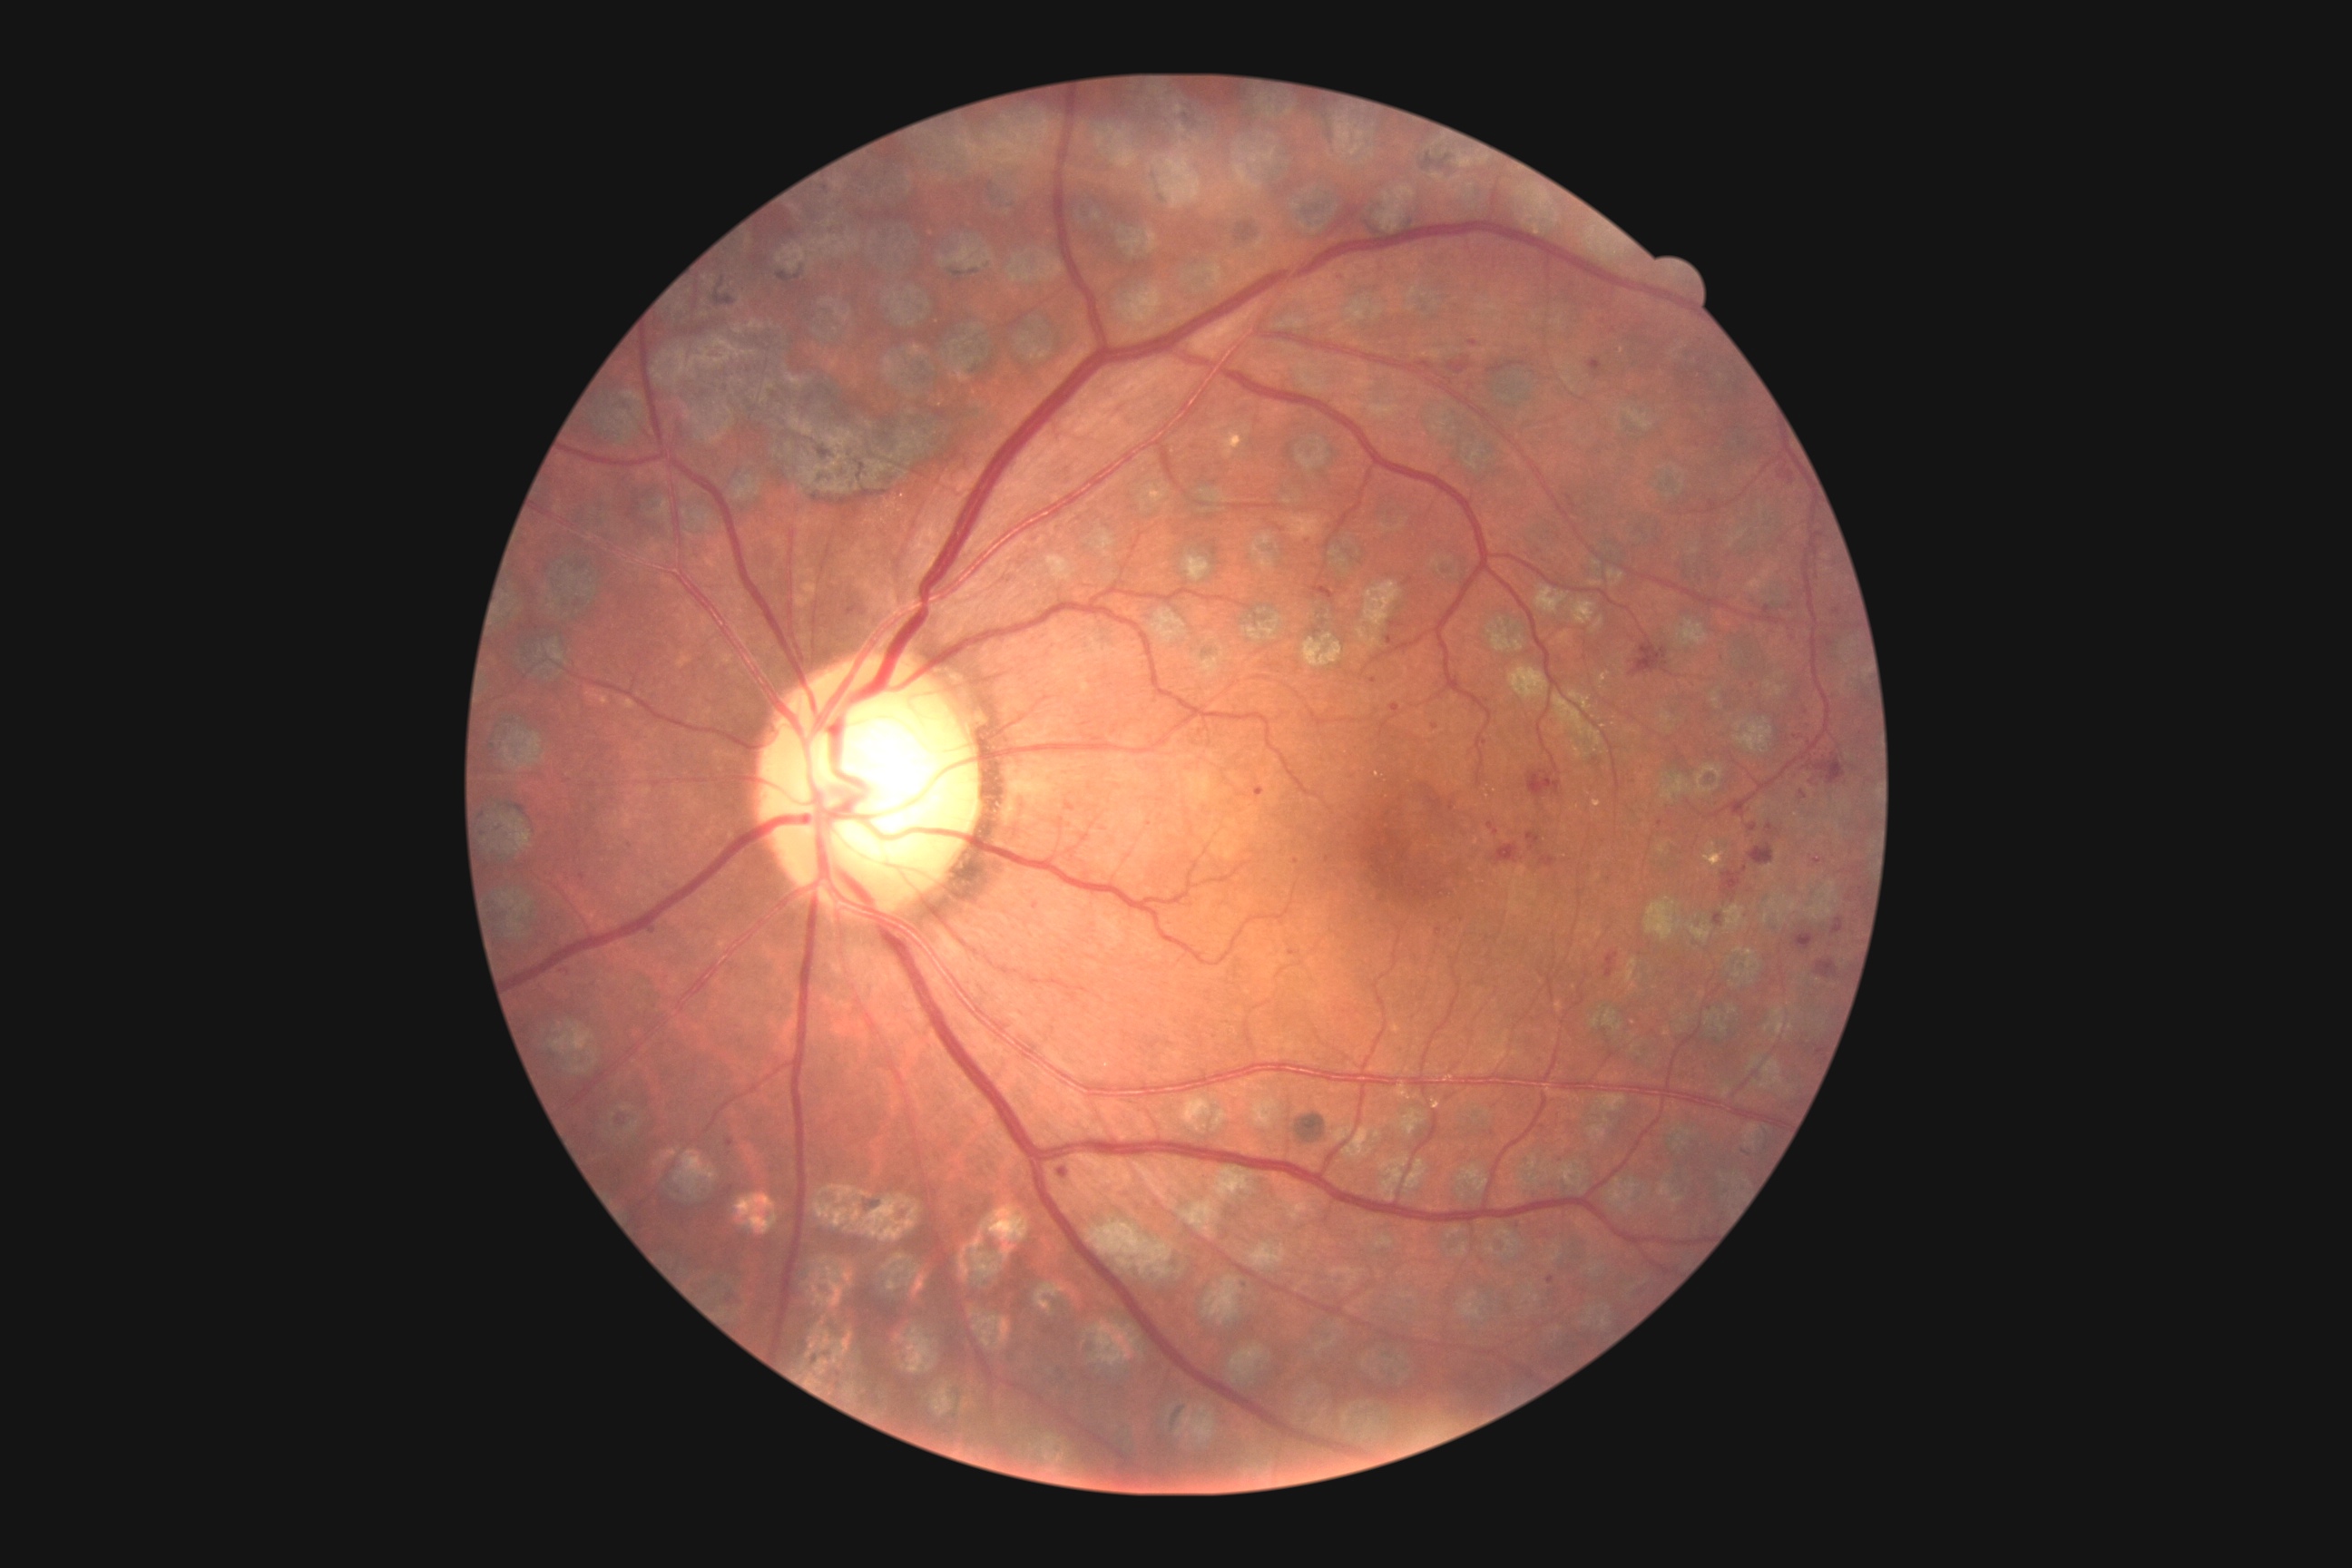

retinopathy grade: moderate non-proliferative diabetic retinopathy (2).